Color fundus image. Nonmydriatic. NIDEK AFC-230. 848x848px — 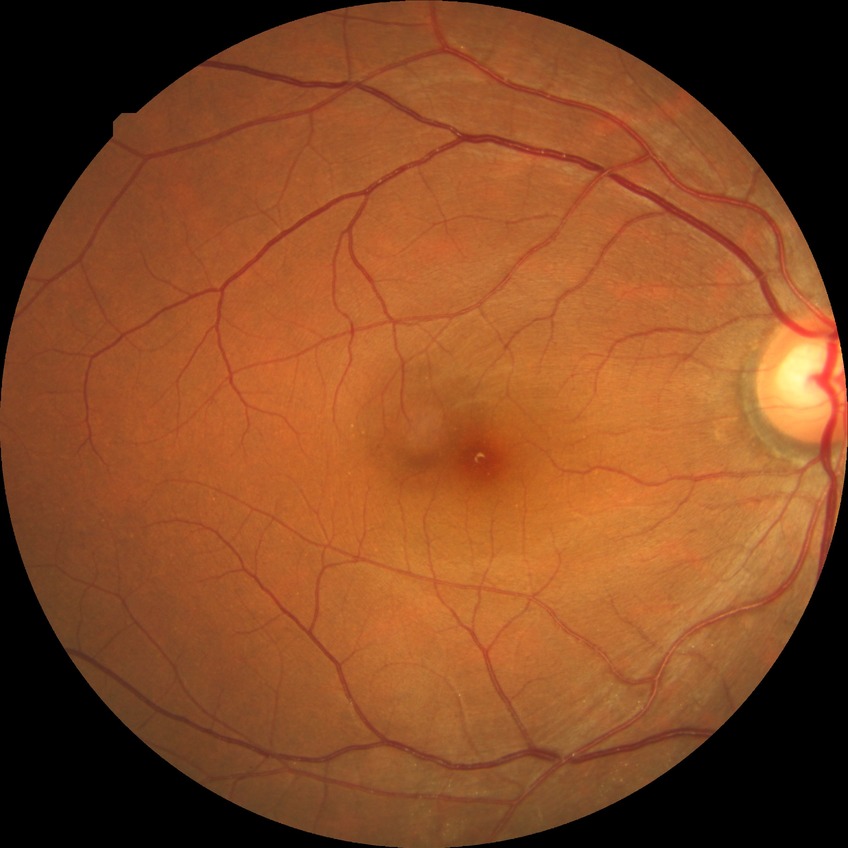

Annotations:
- diabetic retinopathy (DR): SDR (simple diabetic retinopathy)